Modified Davis grading · posterior pole photograph: 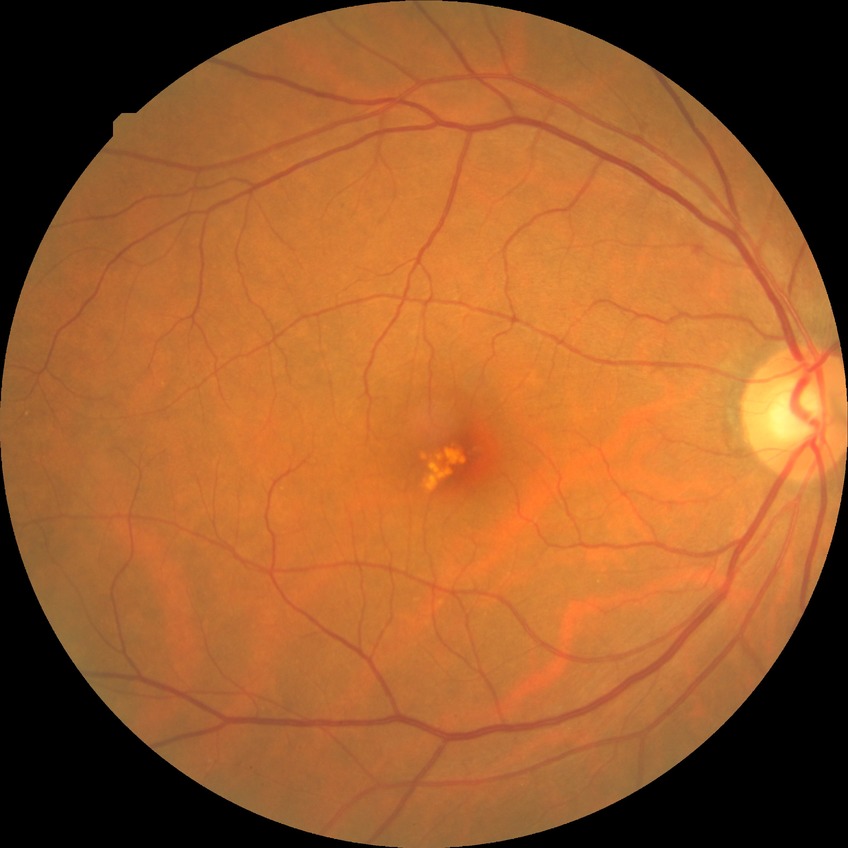 davis_grade: NDR (no diabetic retinopathy)